Retinal fundus photograph: 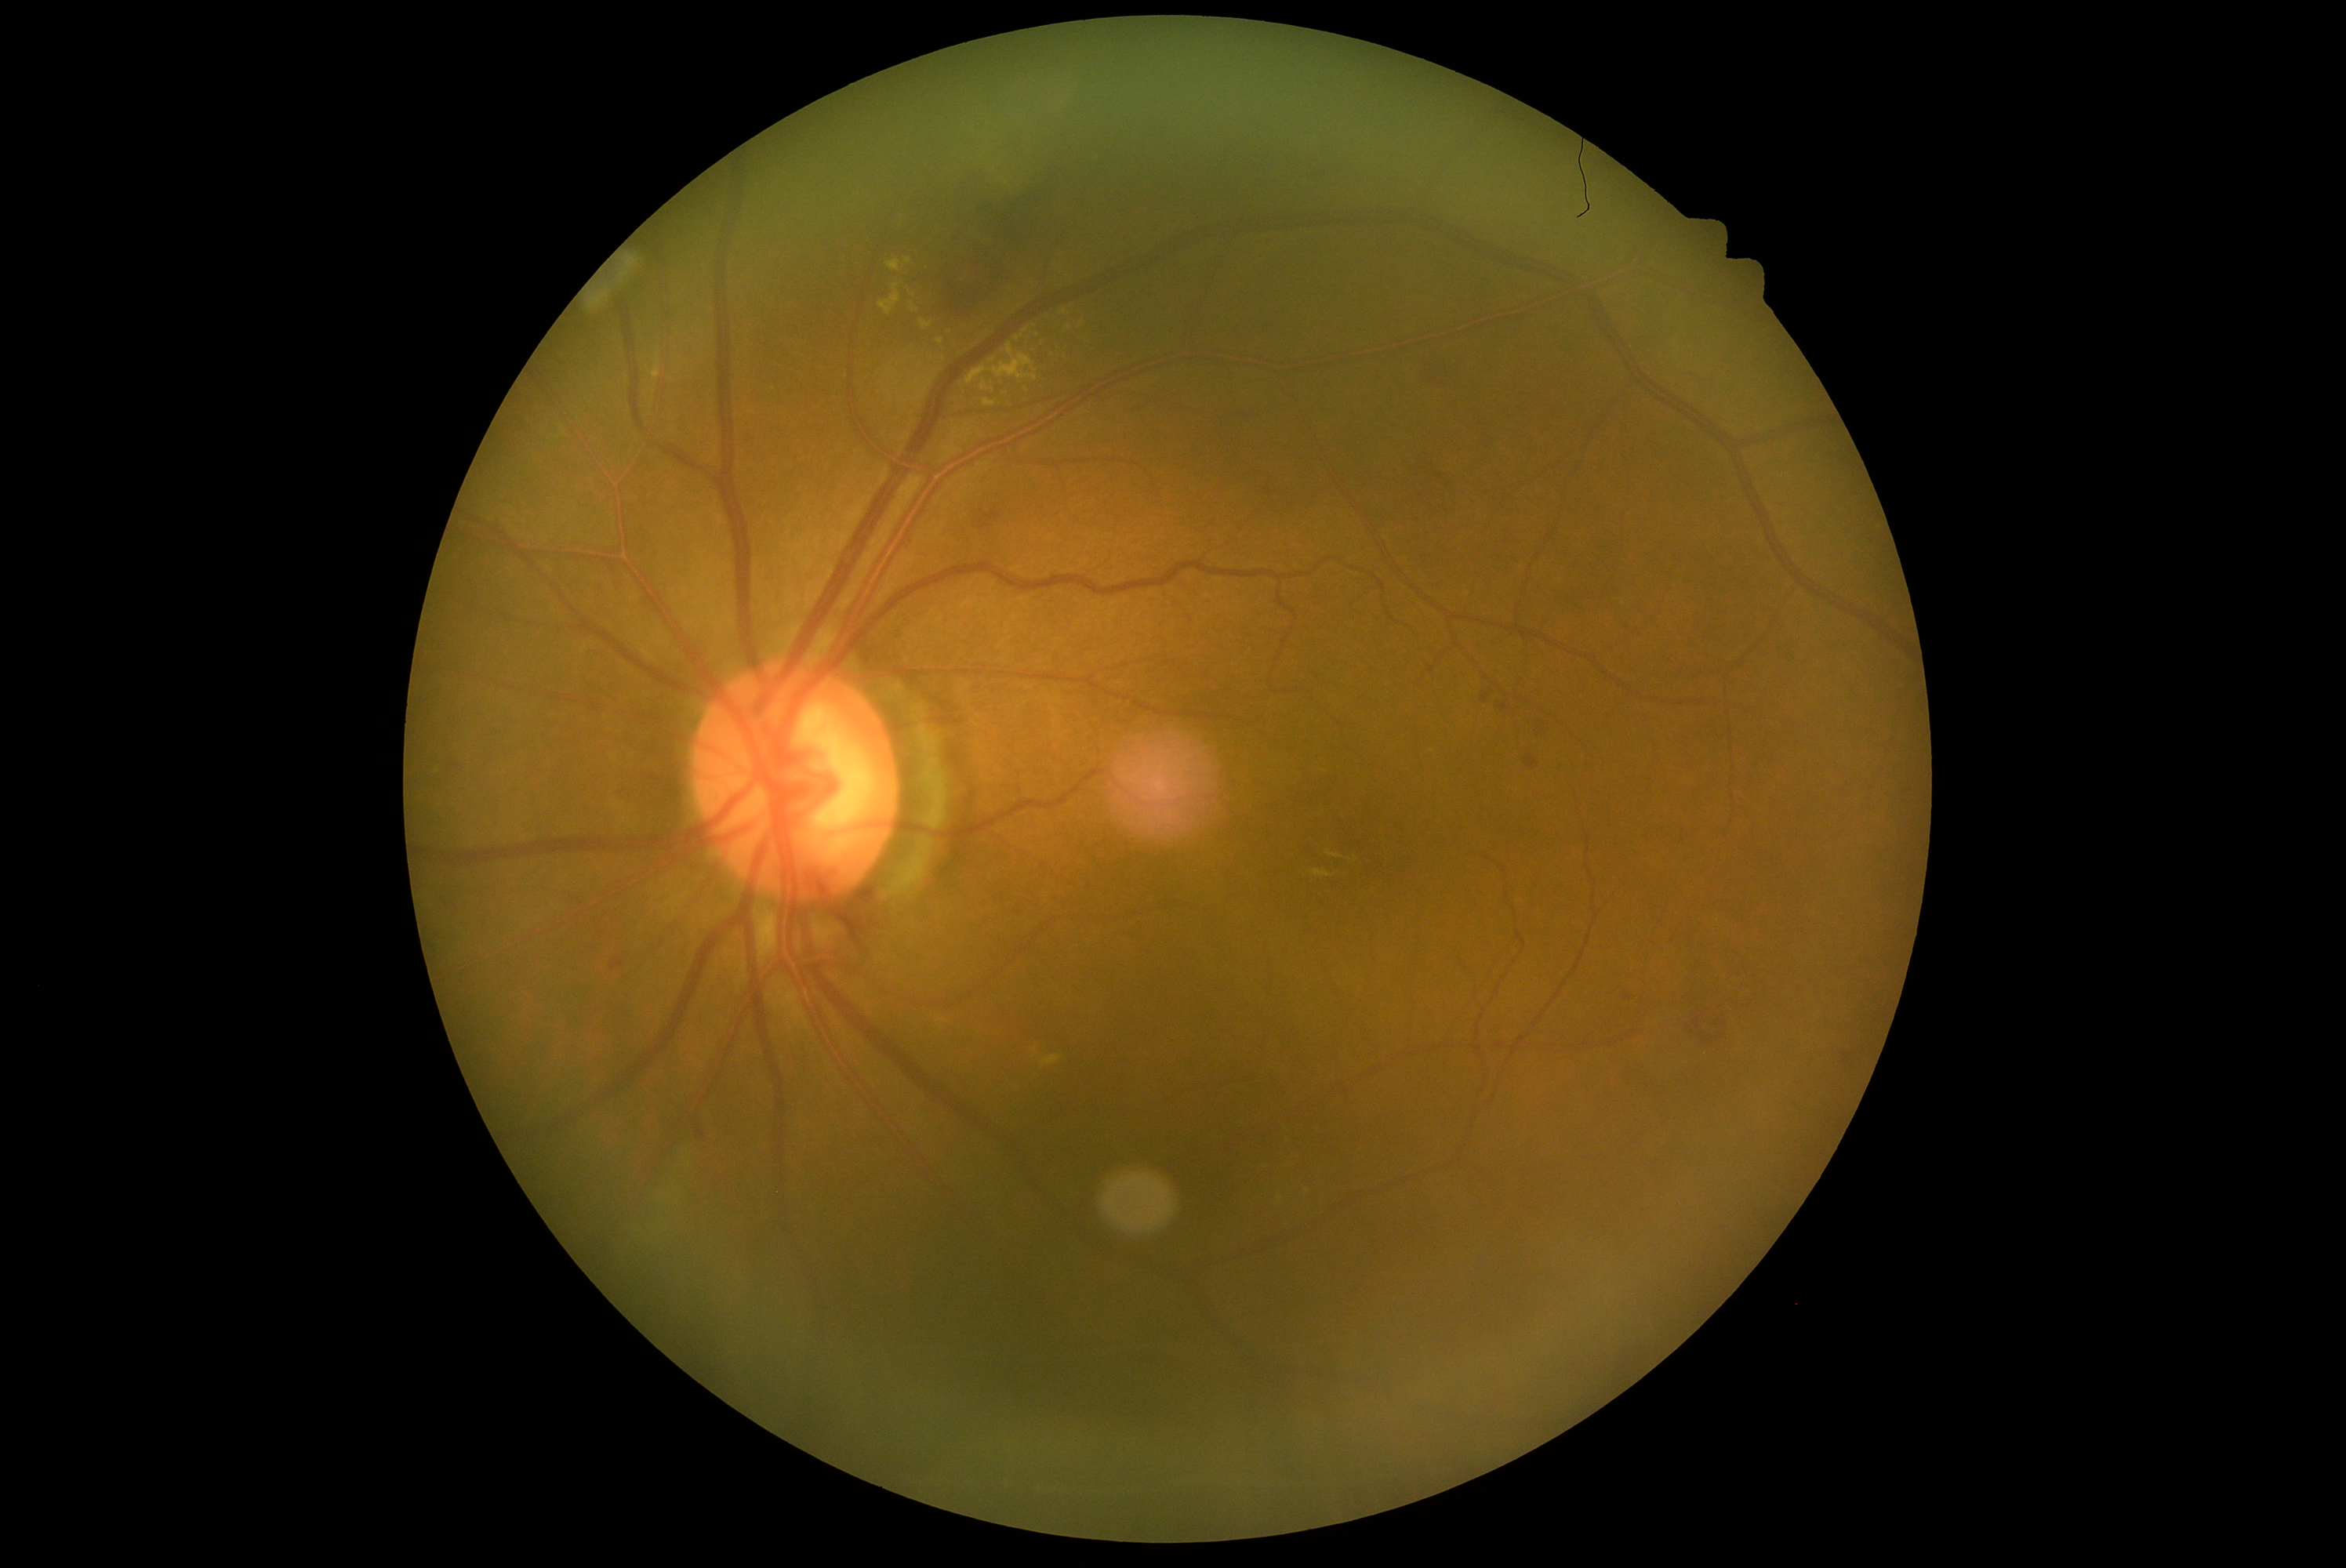 DR grade is 2
A subset of detected lesions:
• EXs (more not shown): [x1=935, y1=1017, x2=948, y2=1029] | [x1=937, y1=339, x2=945, y2=346] | [x1=887, y1=258, x2=912, y2=274] | [x1=965, y1=344, x2=1039, y2=385] | [x1=909, y1=288, x2=917, y2=297] | [x1=981, y1=380, x2=995, y2=394] | [x1=921, y1=319, x2=932, y2=330]
• Additional small EXs near [x=1432, y=751] | [x=993, y=360] | [x=1279, y=1199] | [x=628, y=379]
• SEs: absent
• MAs: absent
• HEs (more not shown): [x1=1666, y1=934, x2=1679, y2=949] | [x1=953, y1=322, x2=1000, y2=360] | [x1=1531, y1=719, x2=1556, y2=739] | [x1=739, y1=424, x2=757, y2=443] | [x1=1616, y1=623, x2=1632, y2=633] | [x1=918, y1=189, x2=1061, y2=319] | [x1=1409, y1=487, x2=1426, y2=501] | [x1=1679, y1=1007, x2=1727, y2=1050] | [x1=1431, y1=473, x2=1456, y2=492] | [x1=1519, y1=746, x2=1542, y2=769] | [x1=1258, y1=476, x2=1284, y2=499] | [x1=1685, y1=938, x2=1693, y2=949]
• Additional small HEs near [x=1850, y=1055]